45° FOV · color fundus photograph.
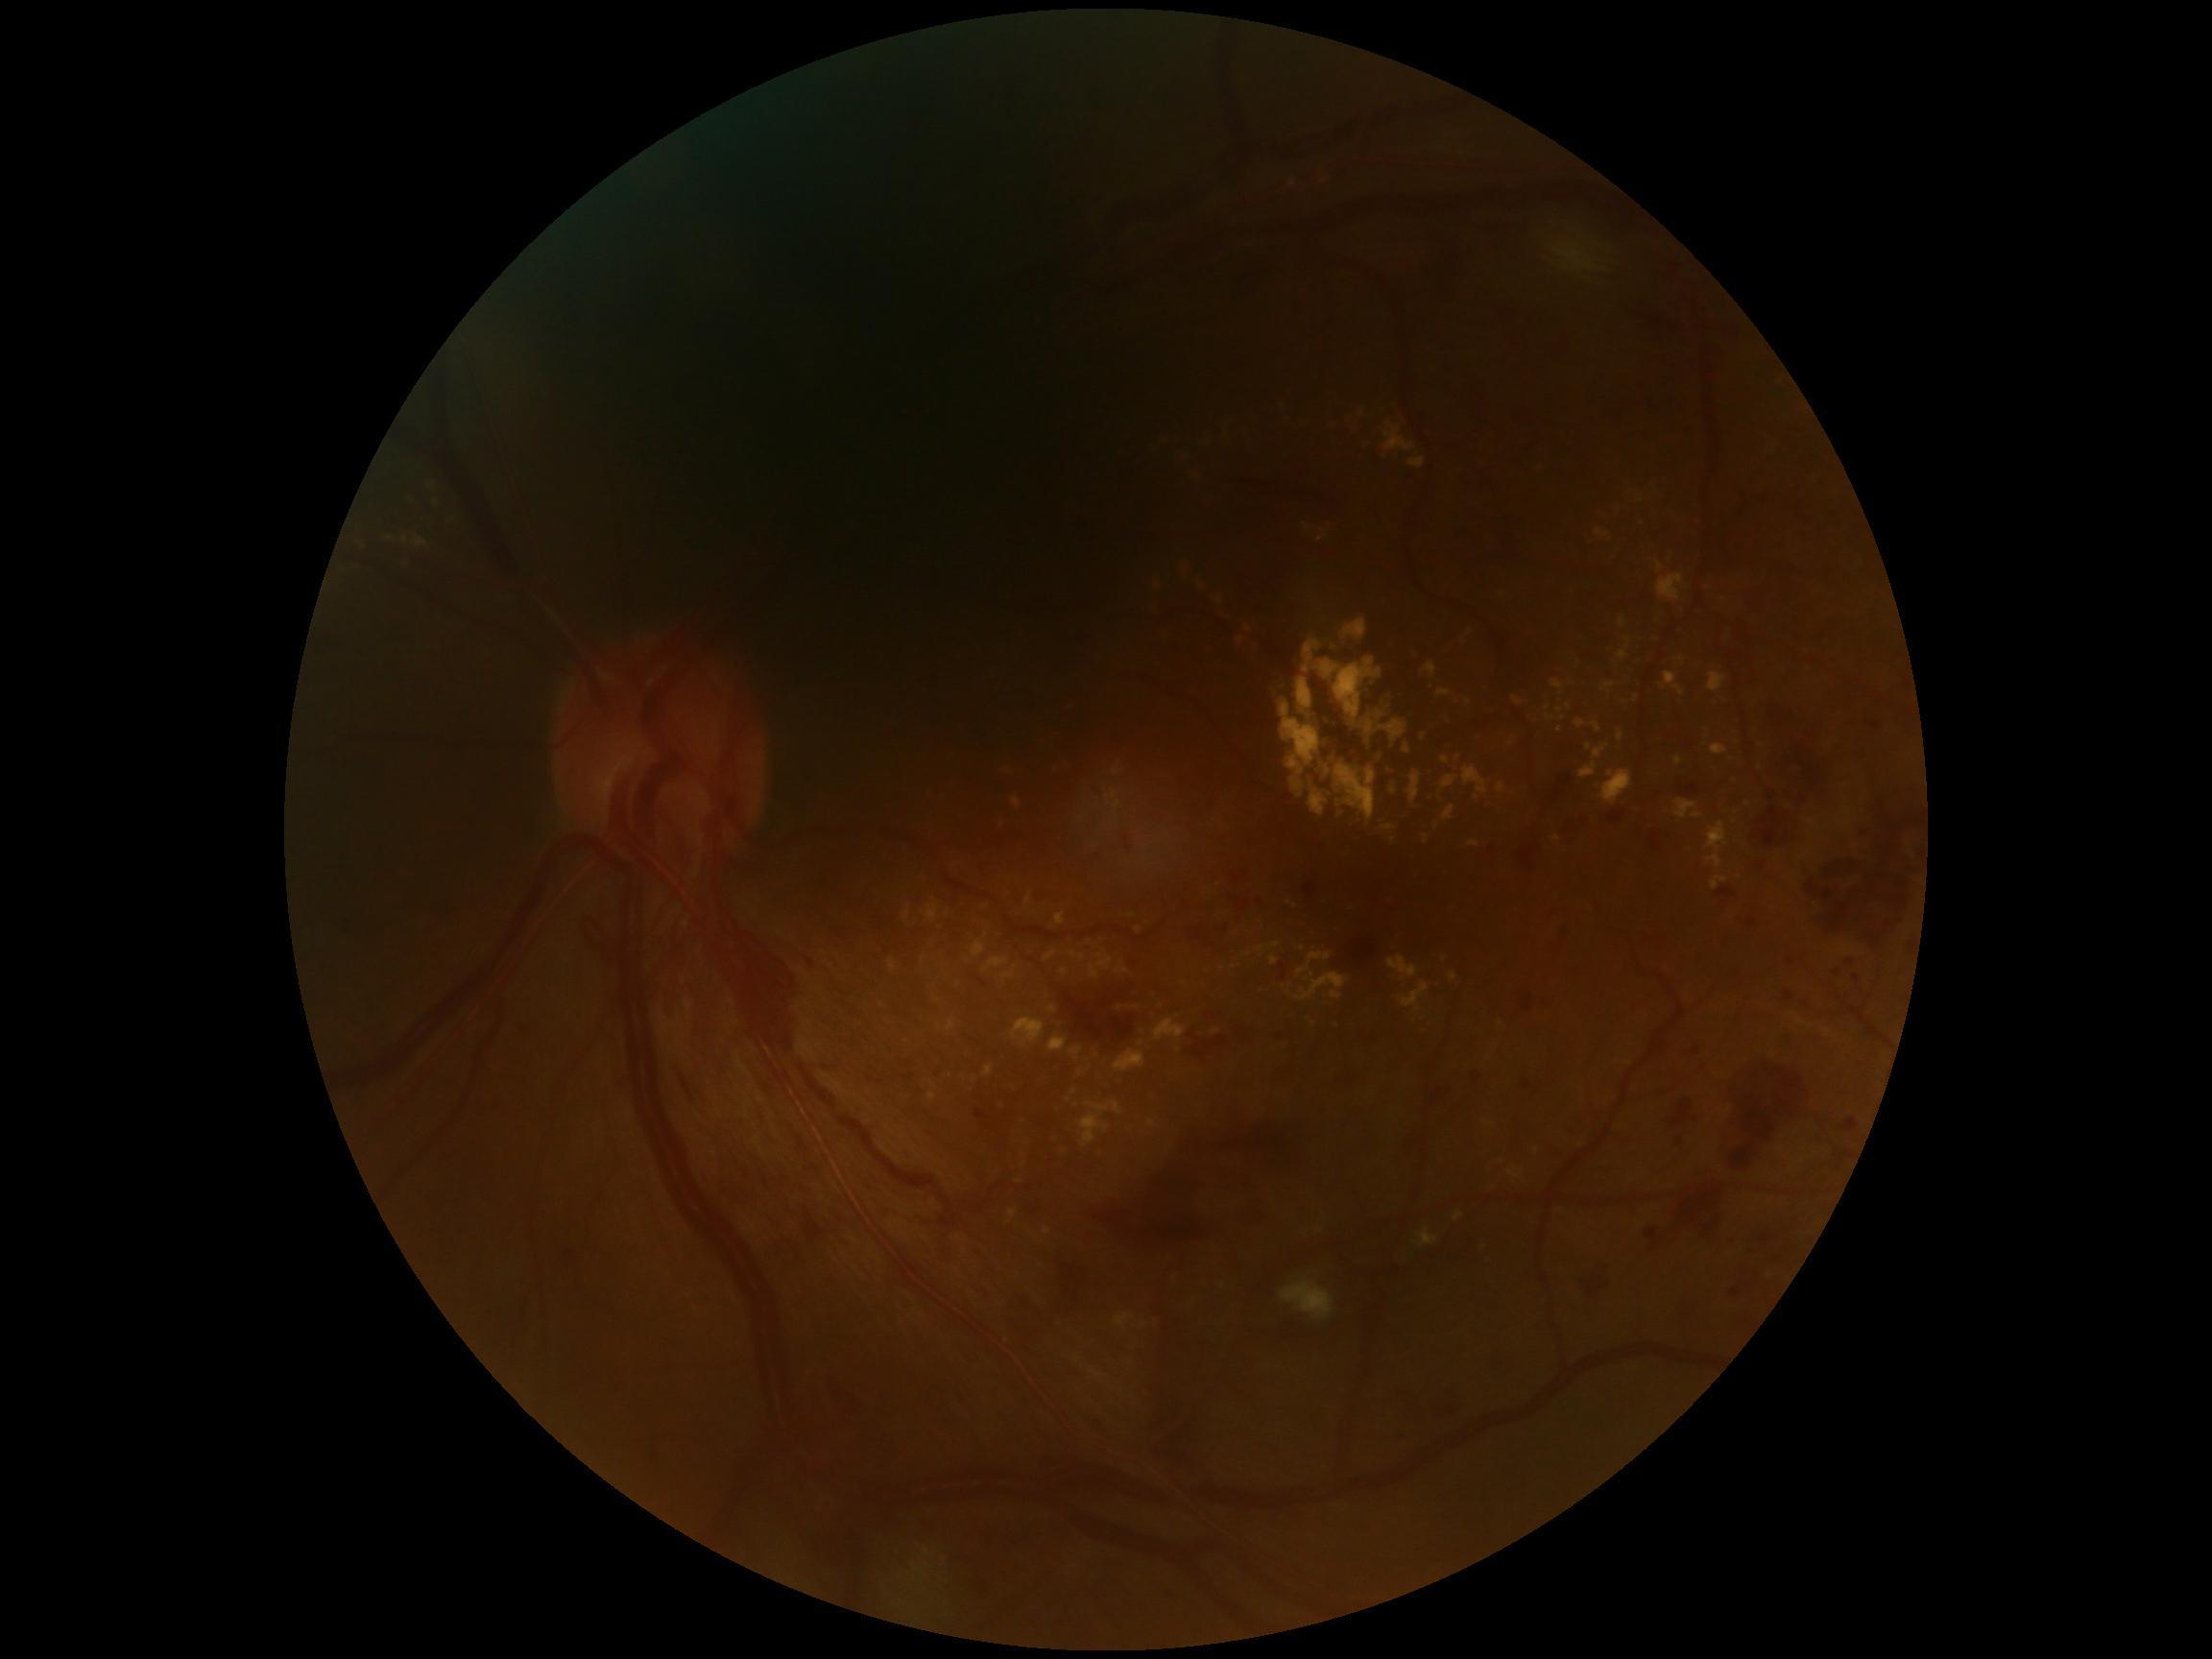
Diabetic retinopathy (DR) is grade 4 — neovascularization and/or vitreous/pre-retinal hemorrhage.